45° FOV. Graded on the modified Davis scale: 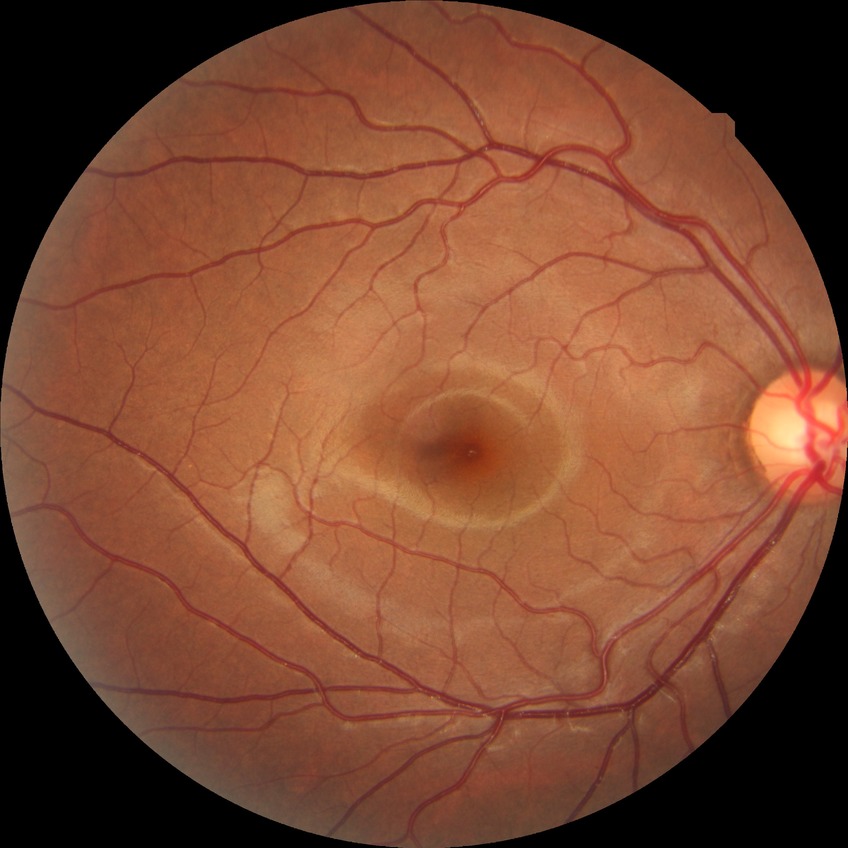

{
  "davis_grade": "NDR"
}